Optic disc region of a color fundus photo — 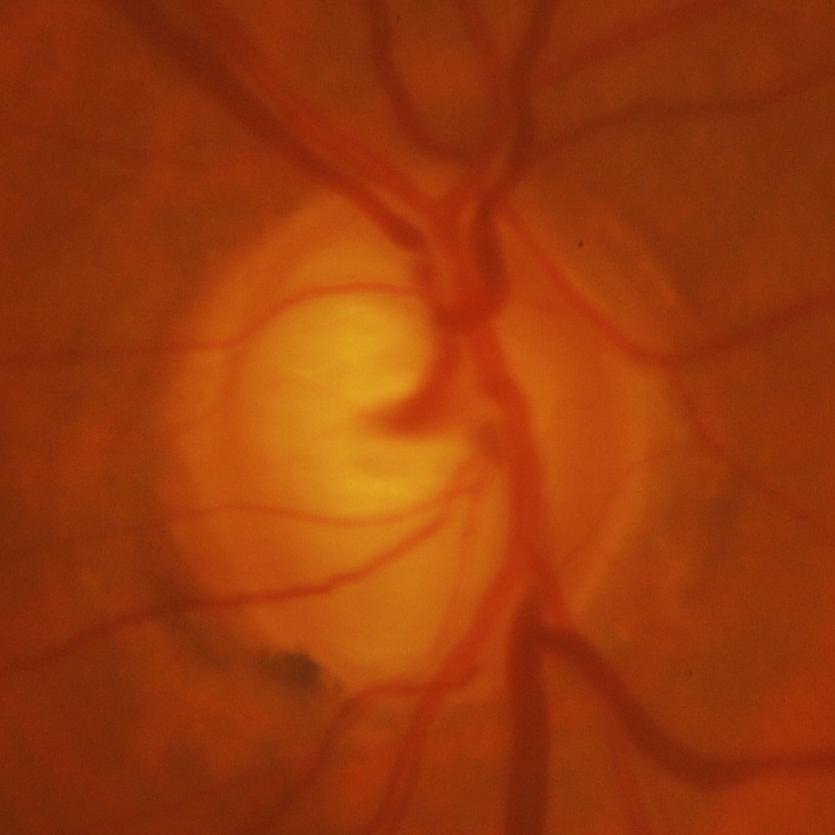 Optic disc appearance consistent with evidence of glaucoma.